Image size 512x512:
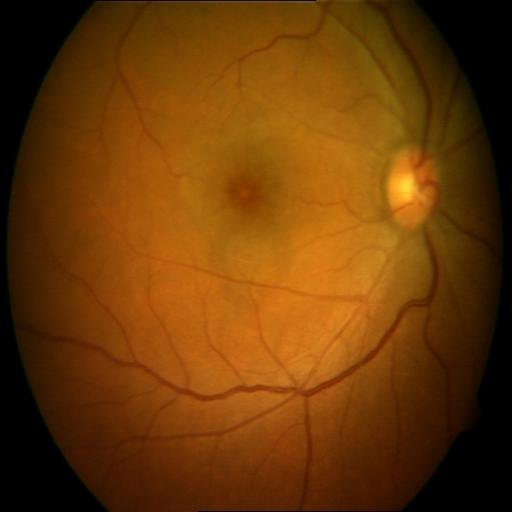
This fundus photograph shows cystoid macular edema.